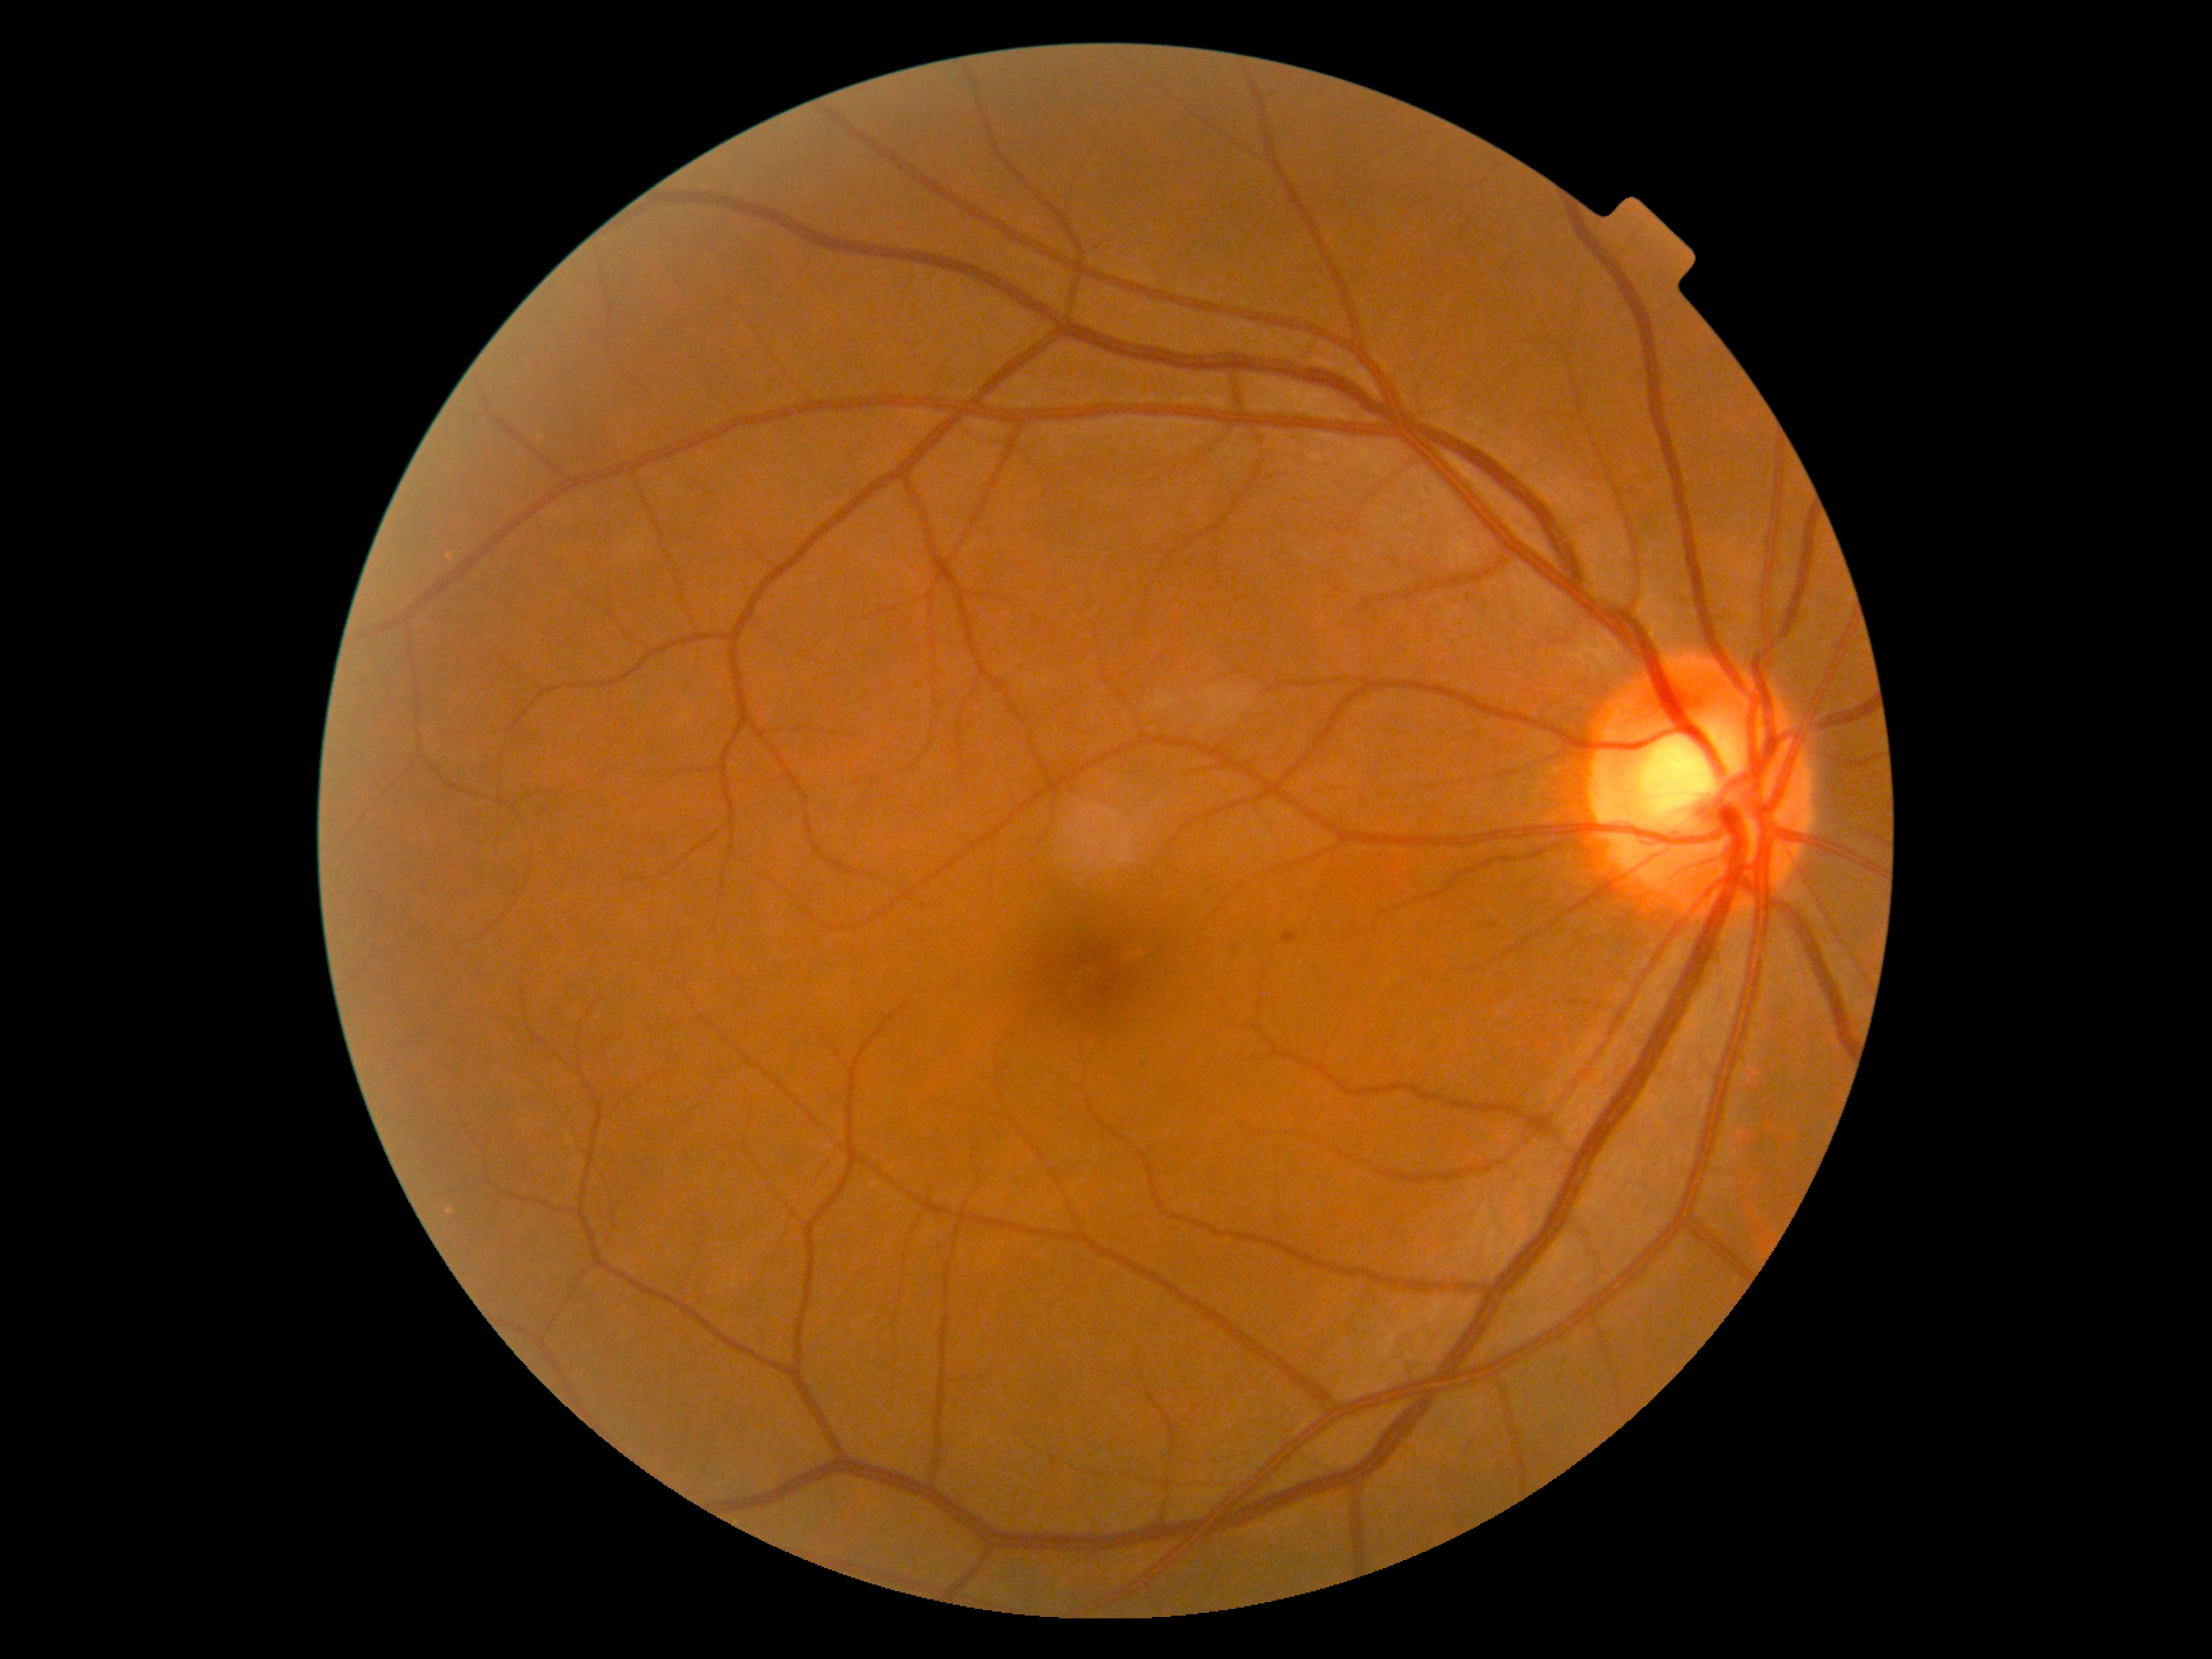

Diabetic retinopathy (DR) is 1; non-proliferative diabetic retinopathy
microaneurysms (MAs): 1231 947 1240 955 | 1282 932 1299 944 | 1485 918 1501 932 | 1138 1057 1143 1069
MAs (small, approximate centers) near <pt>1013,1036</pt>
hemorrhages (HEs): absent
hard exudates (EXs): absent
soft exudates (SEs): absent